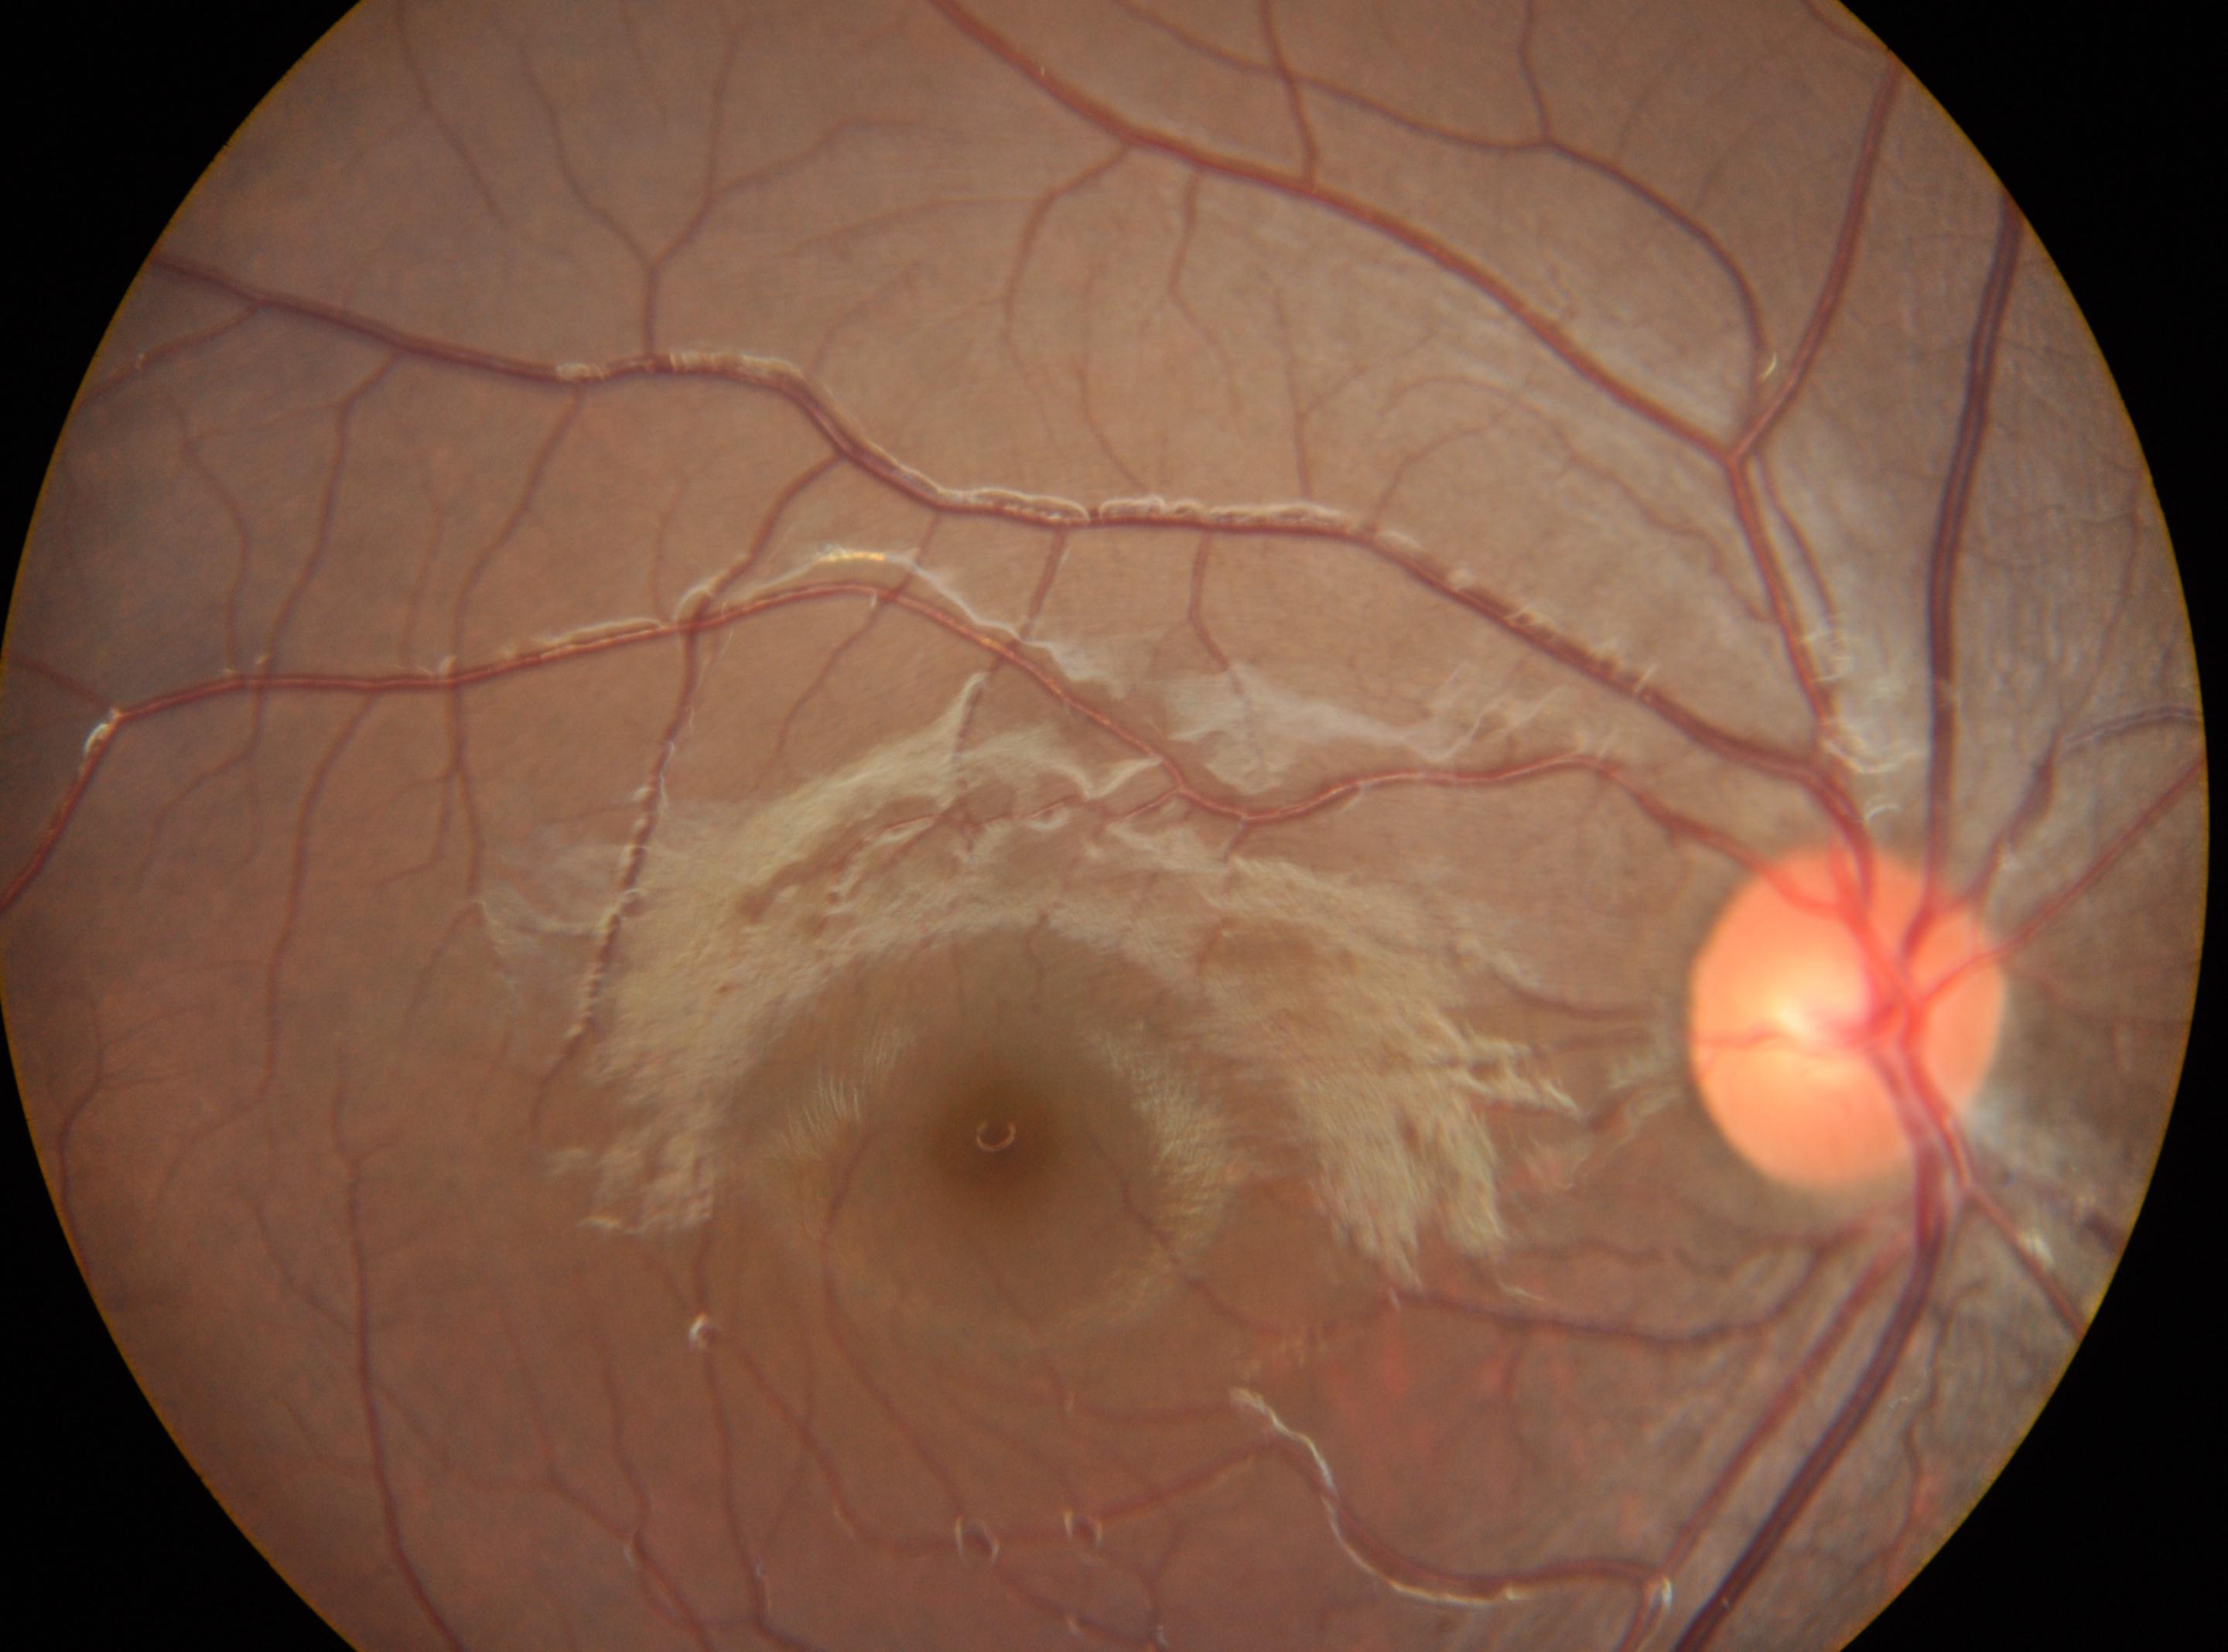

Diabetic retinopathy is no apparent diabetic retinopathy (grade 0).
Optic nerve head located at [1846, 1012].
The fovea is at [995, 1134].
No apparent diabetic retinopathy.
The image shows the oculus dexter.